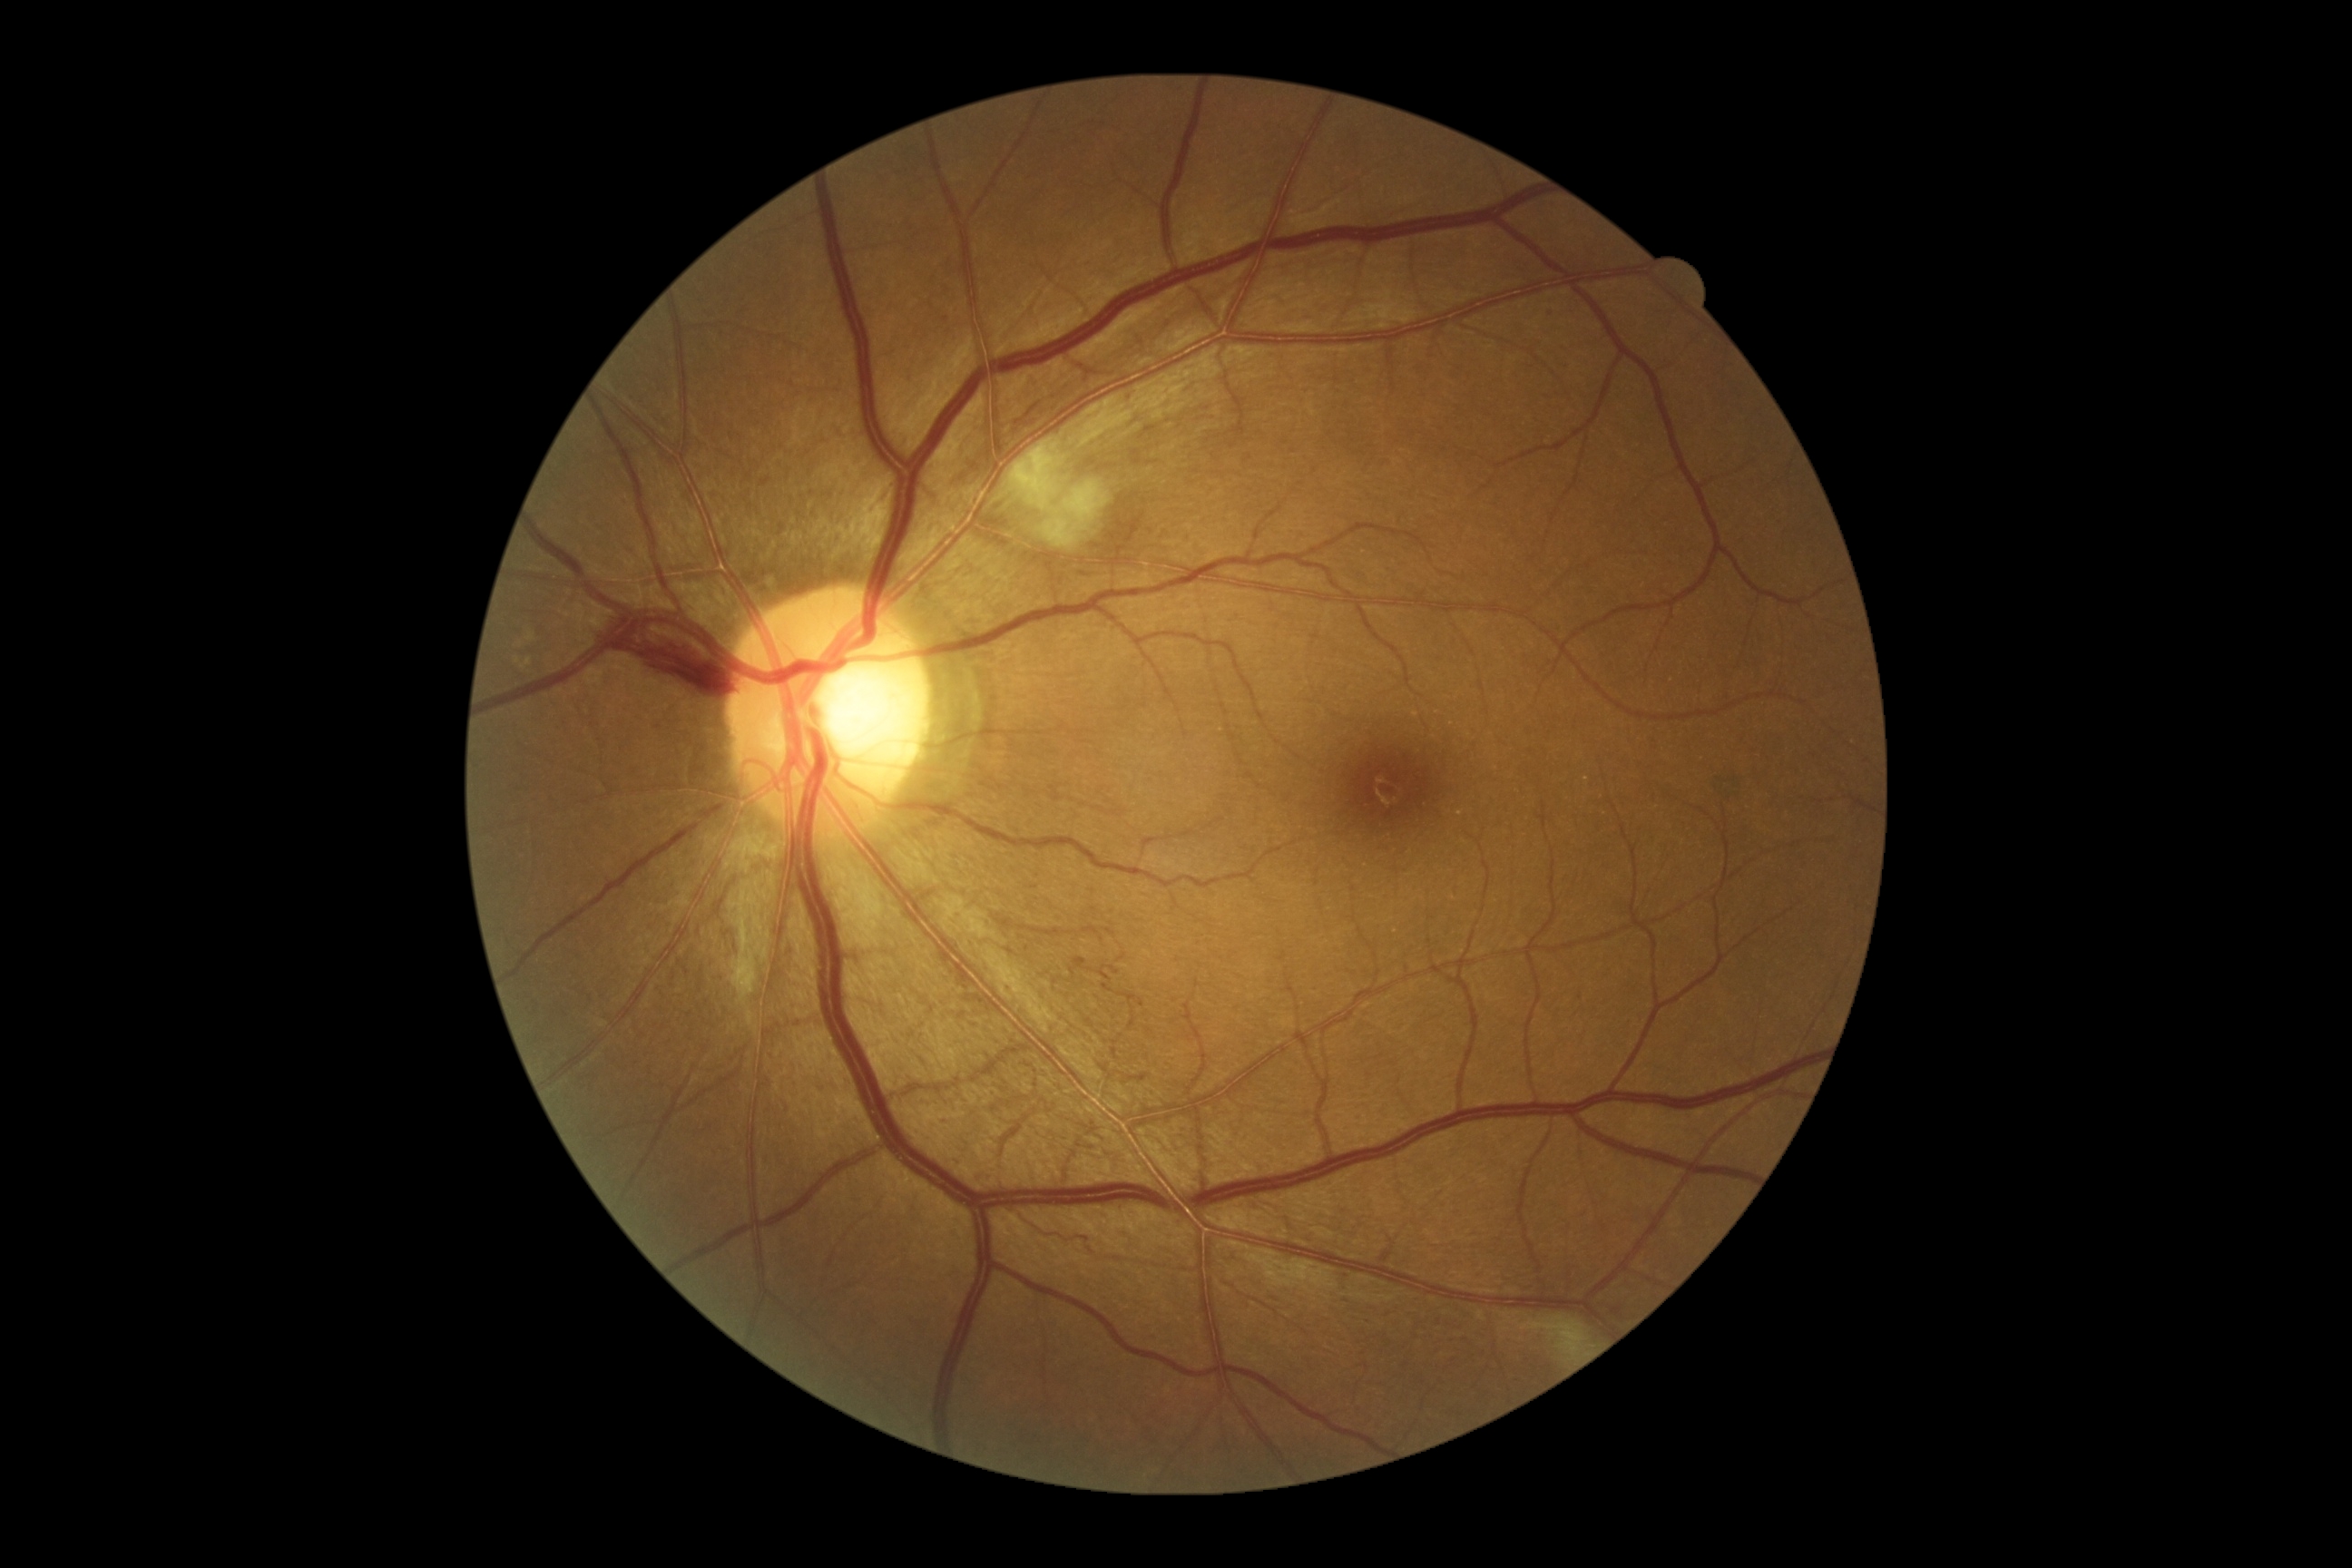

Retinopathy grade is 2 (moderate NPDR) — more than just microaneurysms but less than severe NPDR. DR class: non-proliferative diabetic retinopathy.